45° field of view
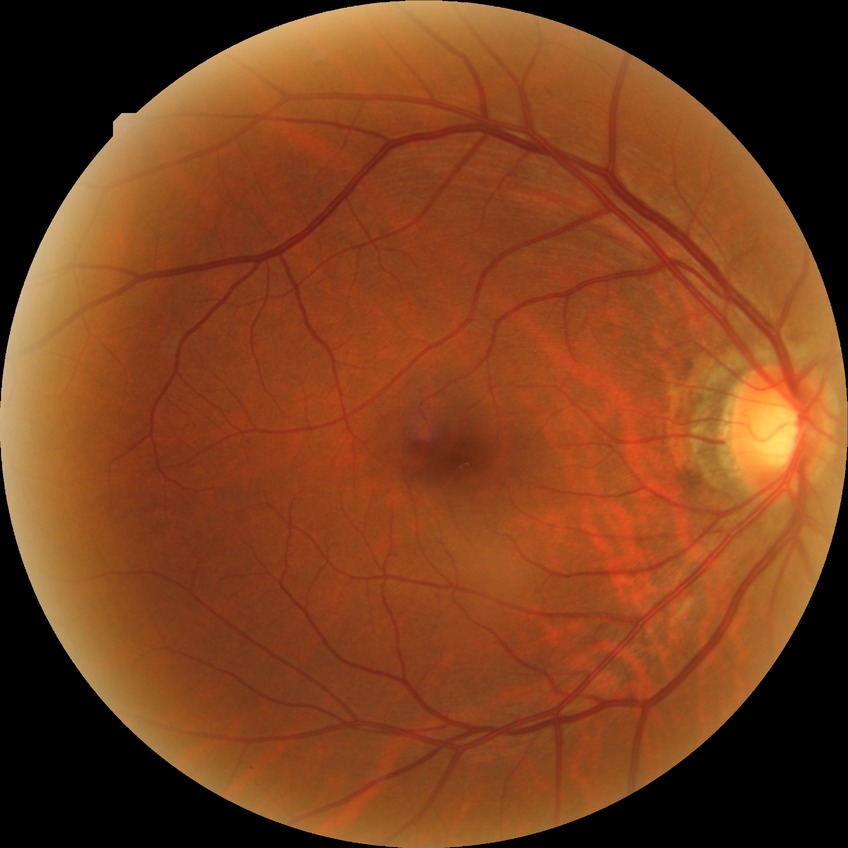
Davis DR grade is SDR.